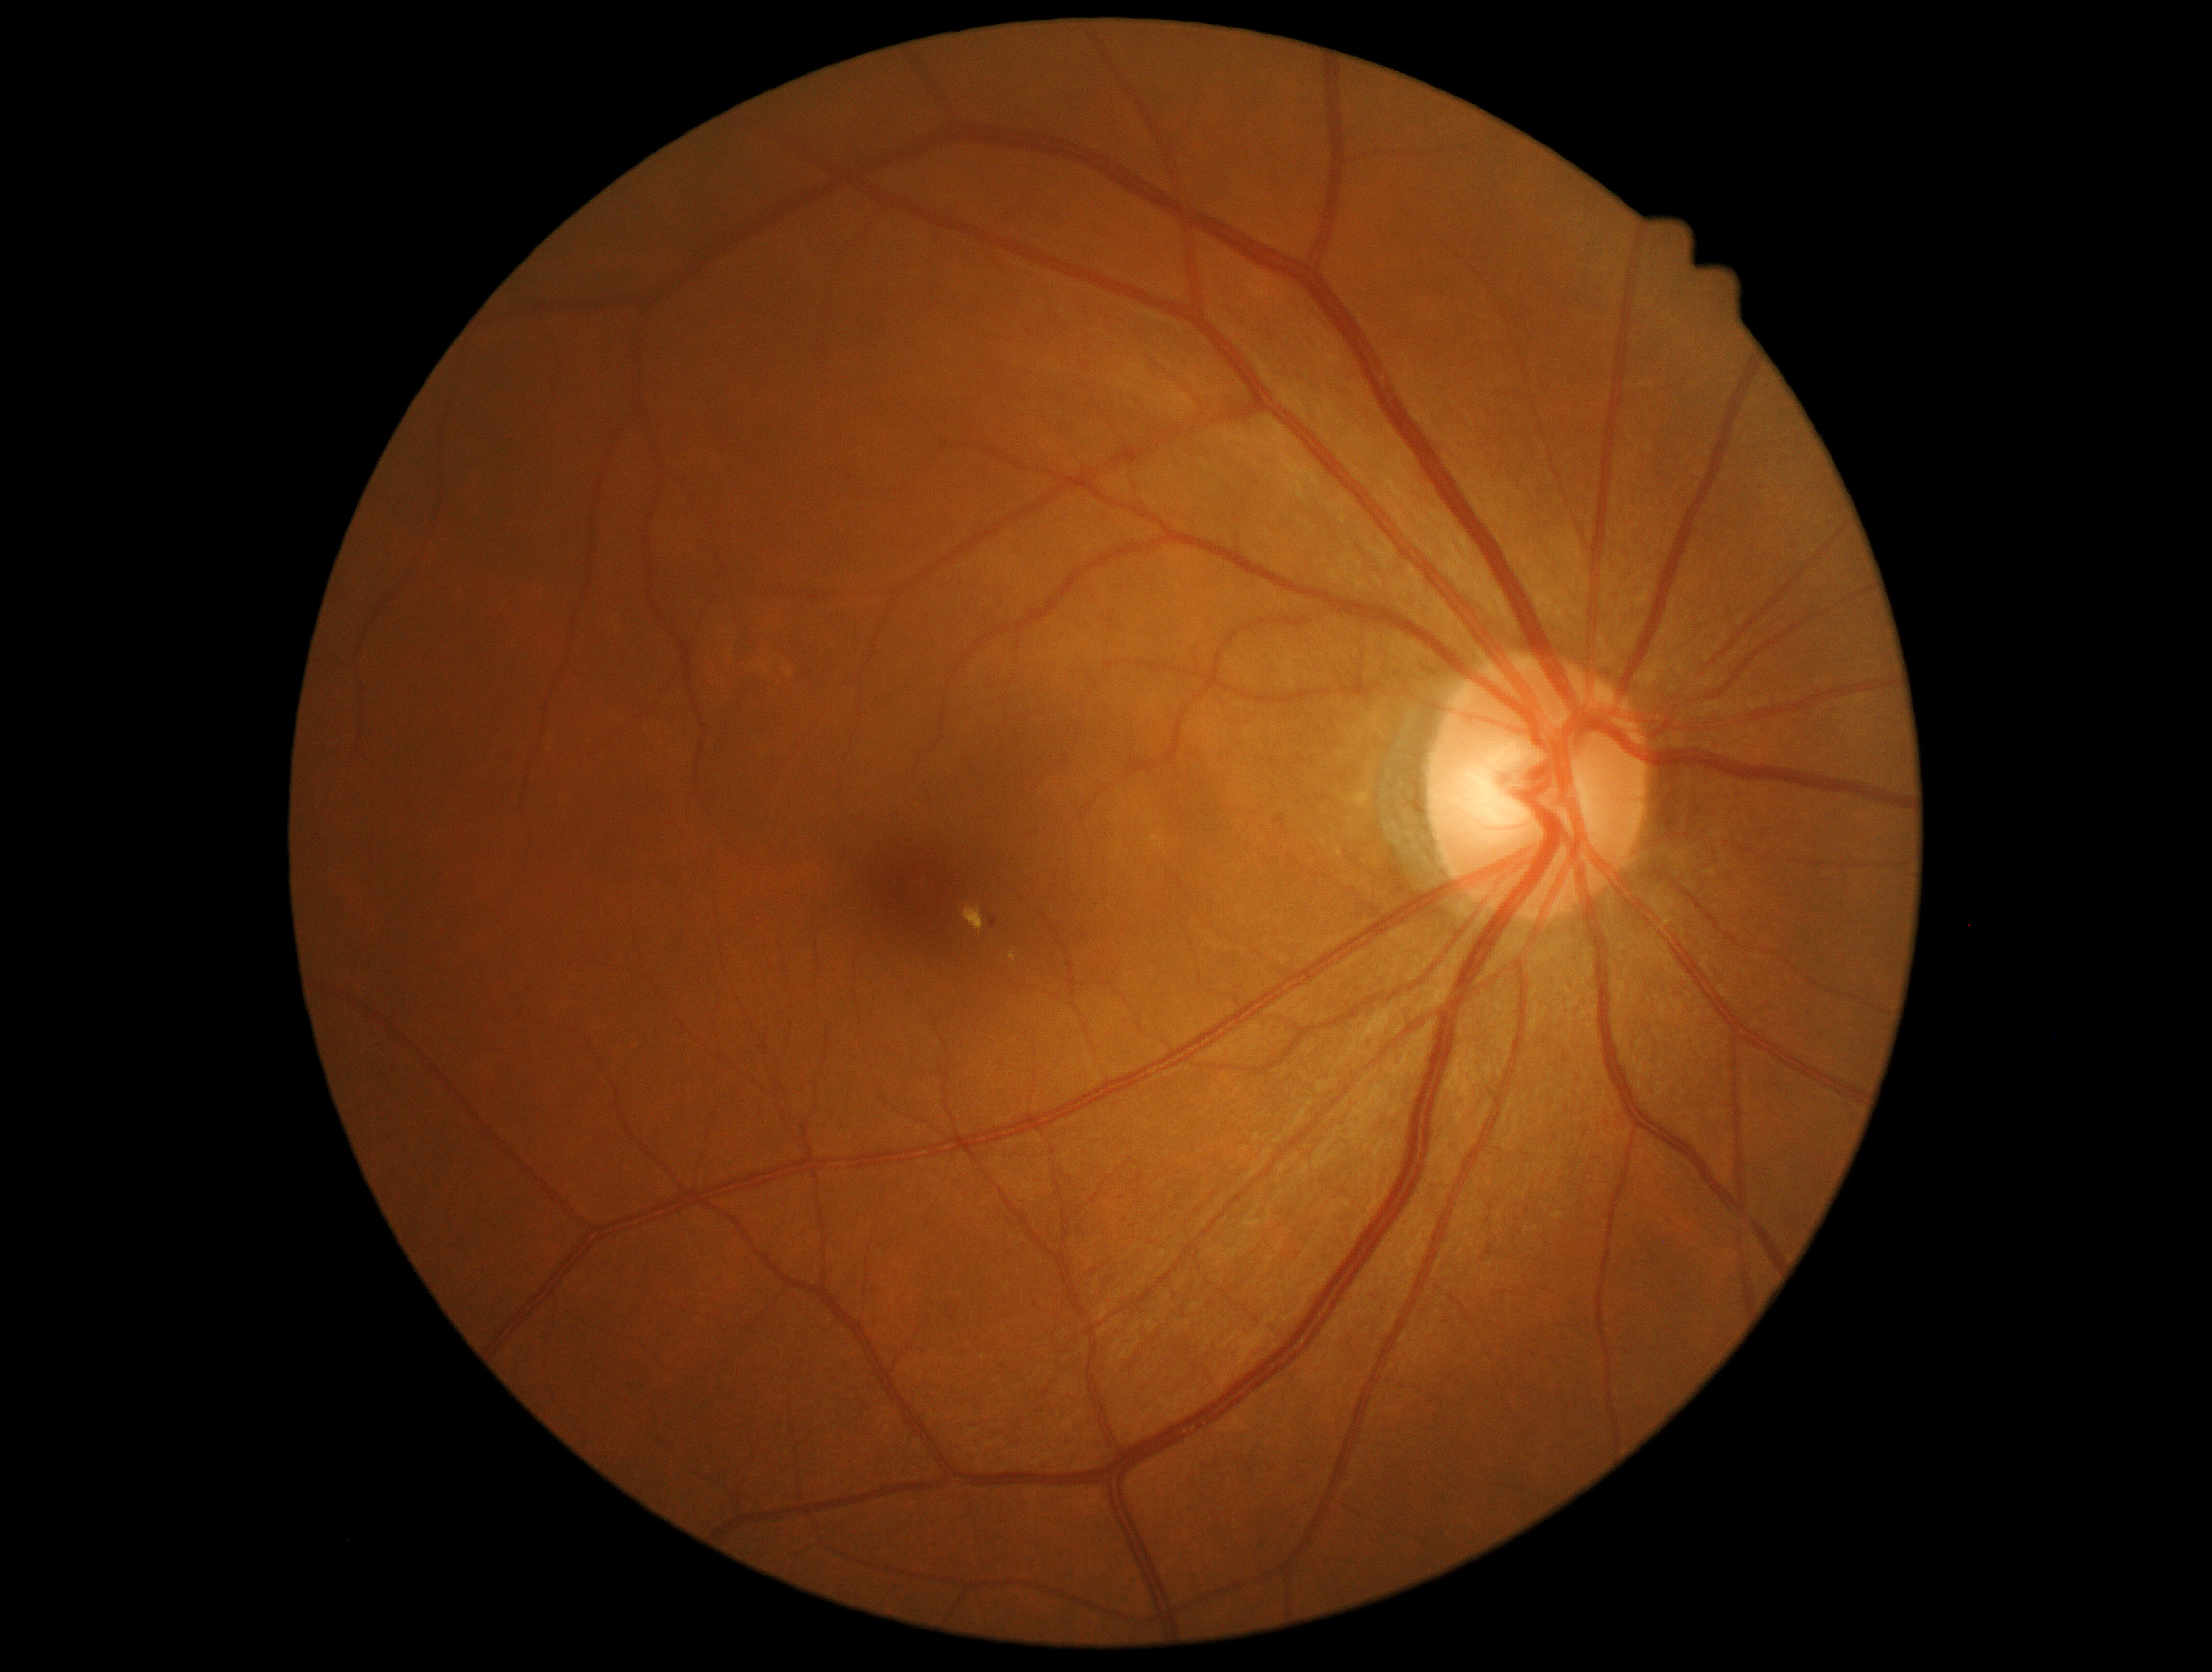 DR stage: grade 2.